Davis DR grading — 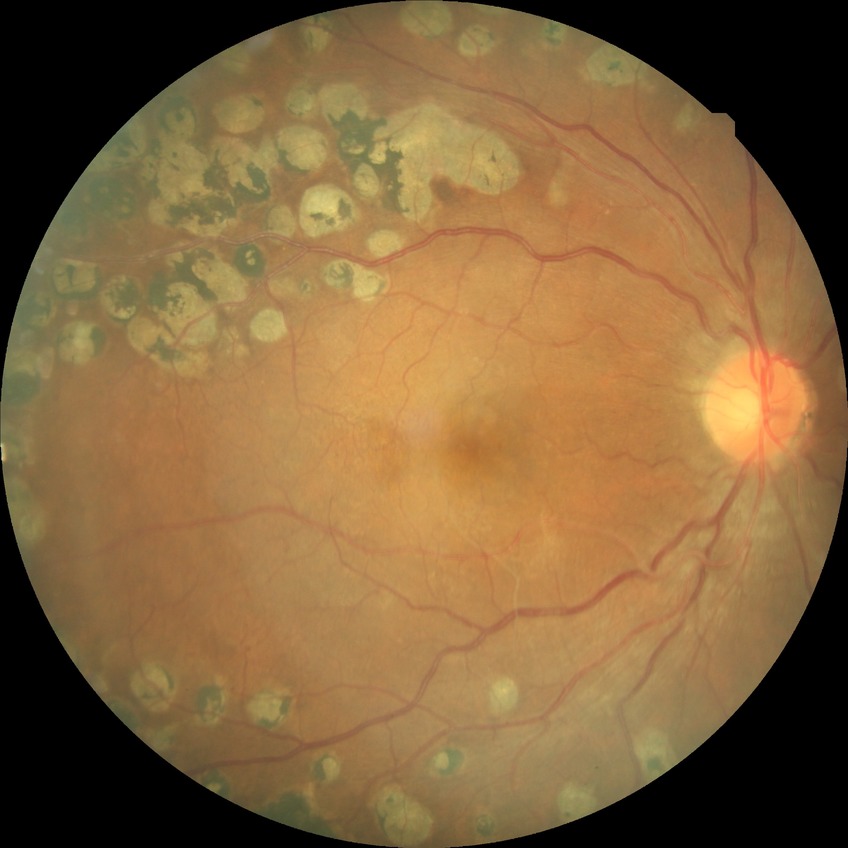 Diabetic retinopathy (DR) is proliferative diabetic retinopathy (PDR).